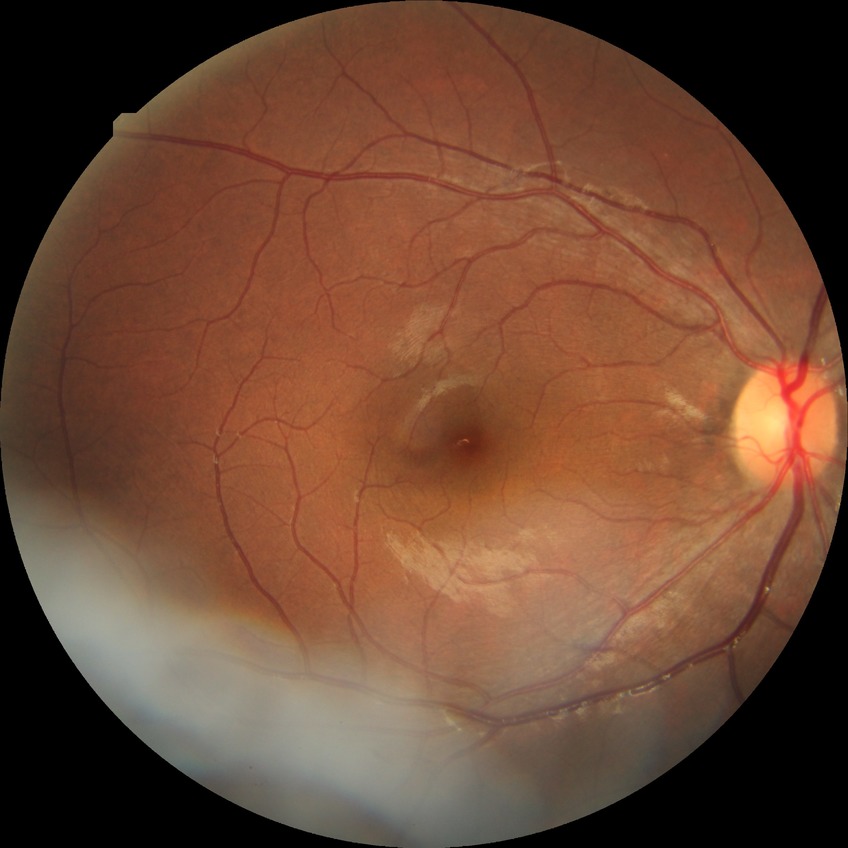
Davis grading: simple diabetic retinopathy.